Retinal fundus photograph:
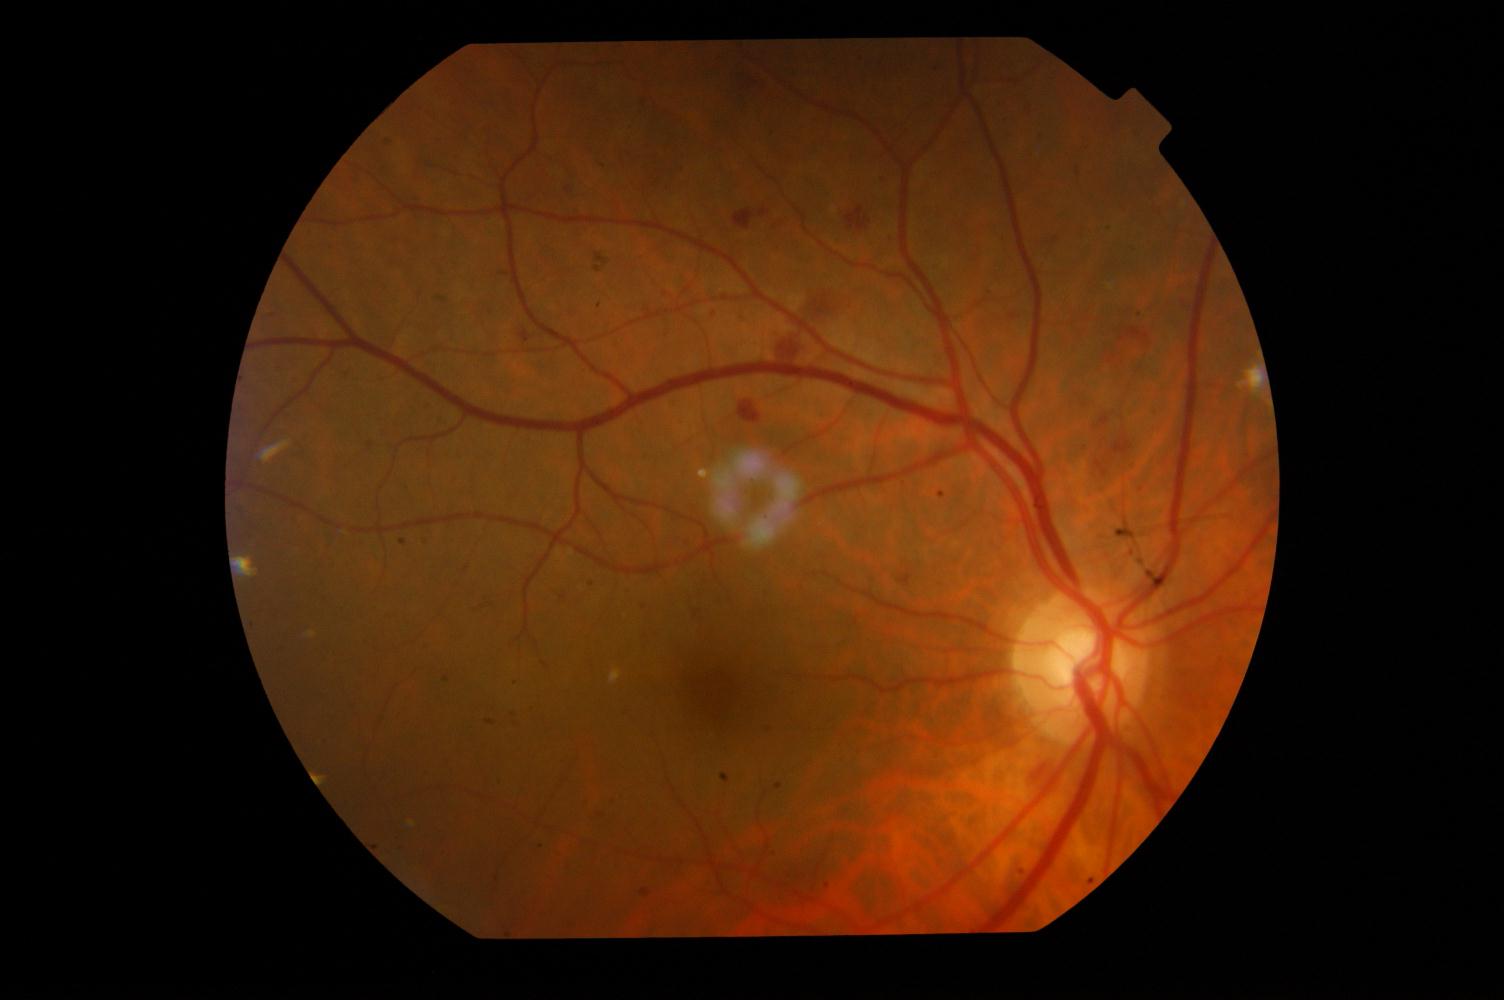 Findings: diabetic retinopathy.